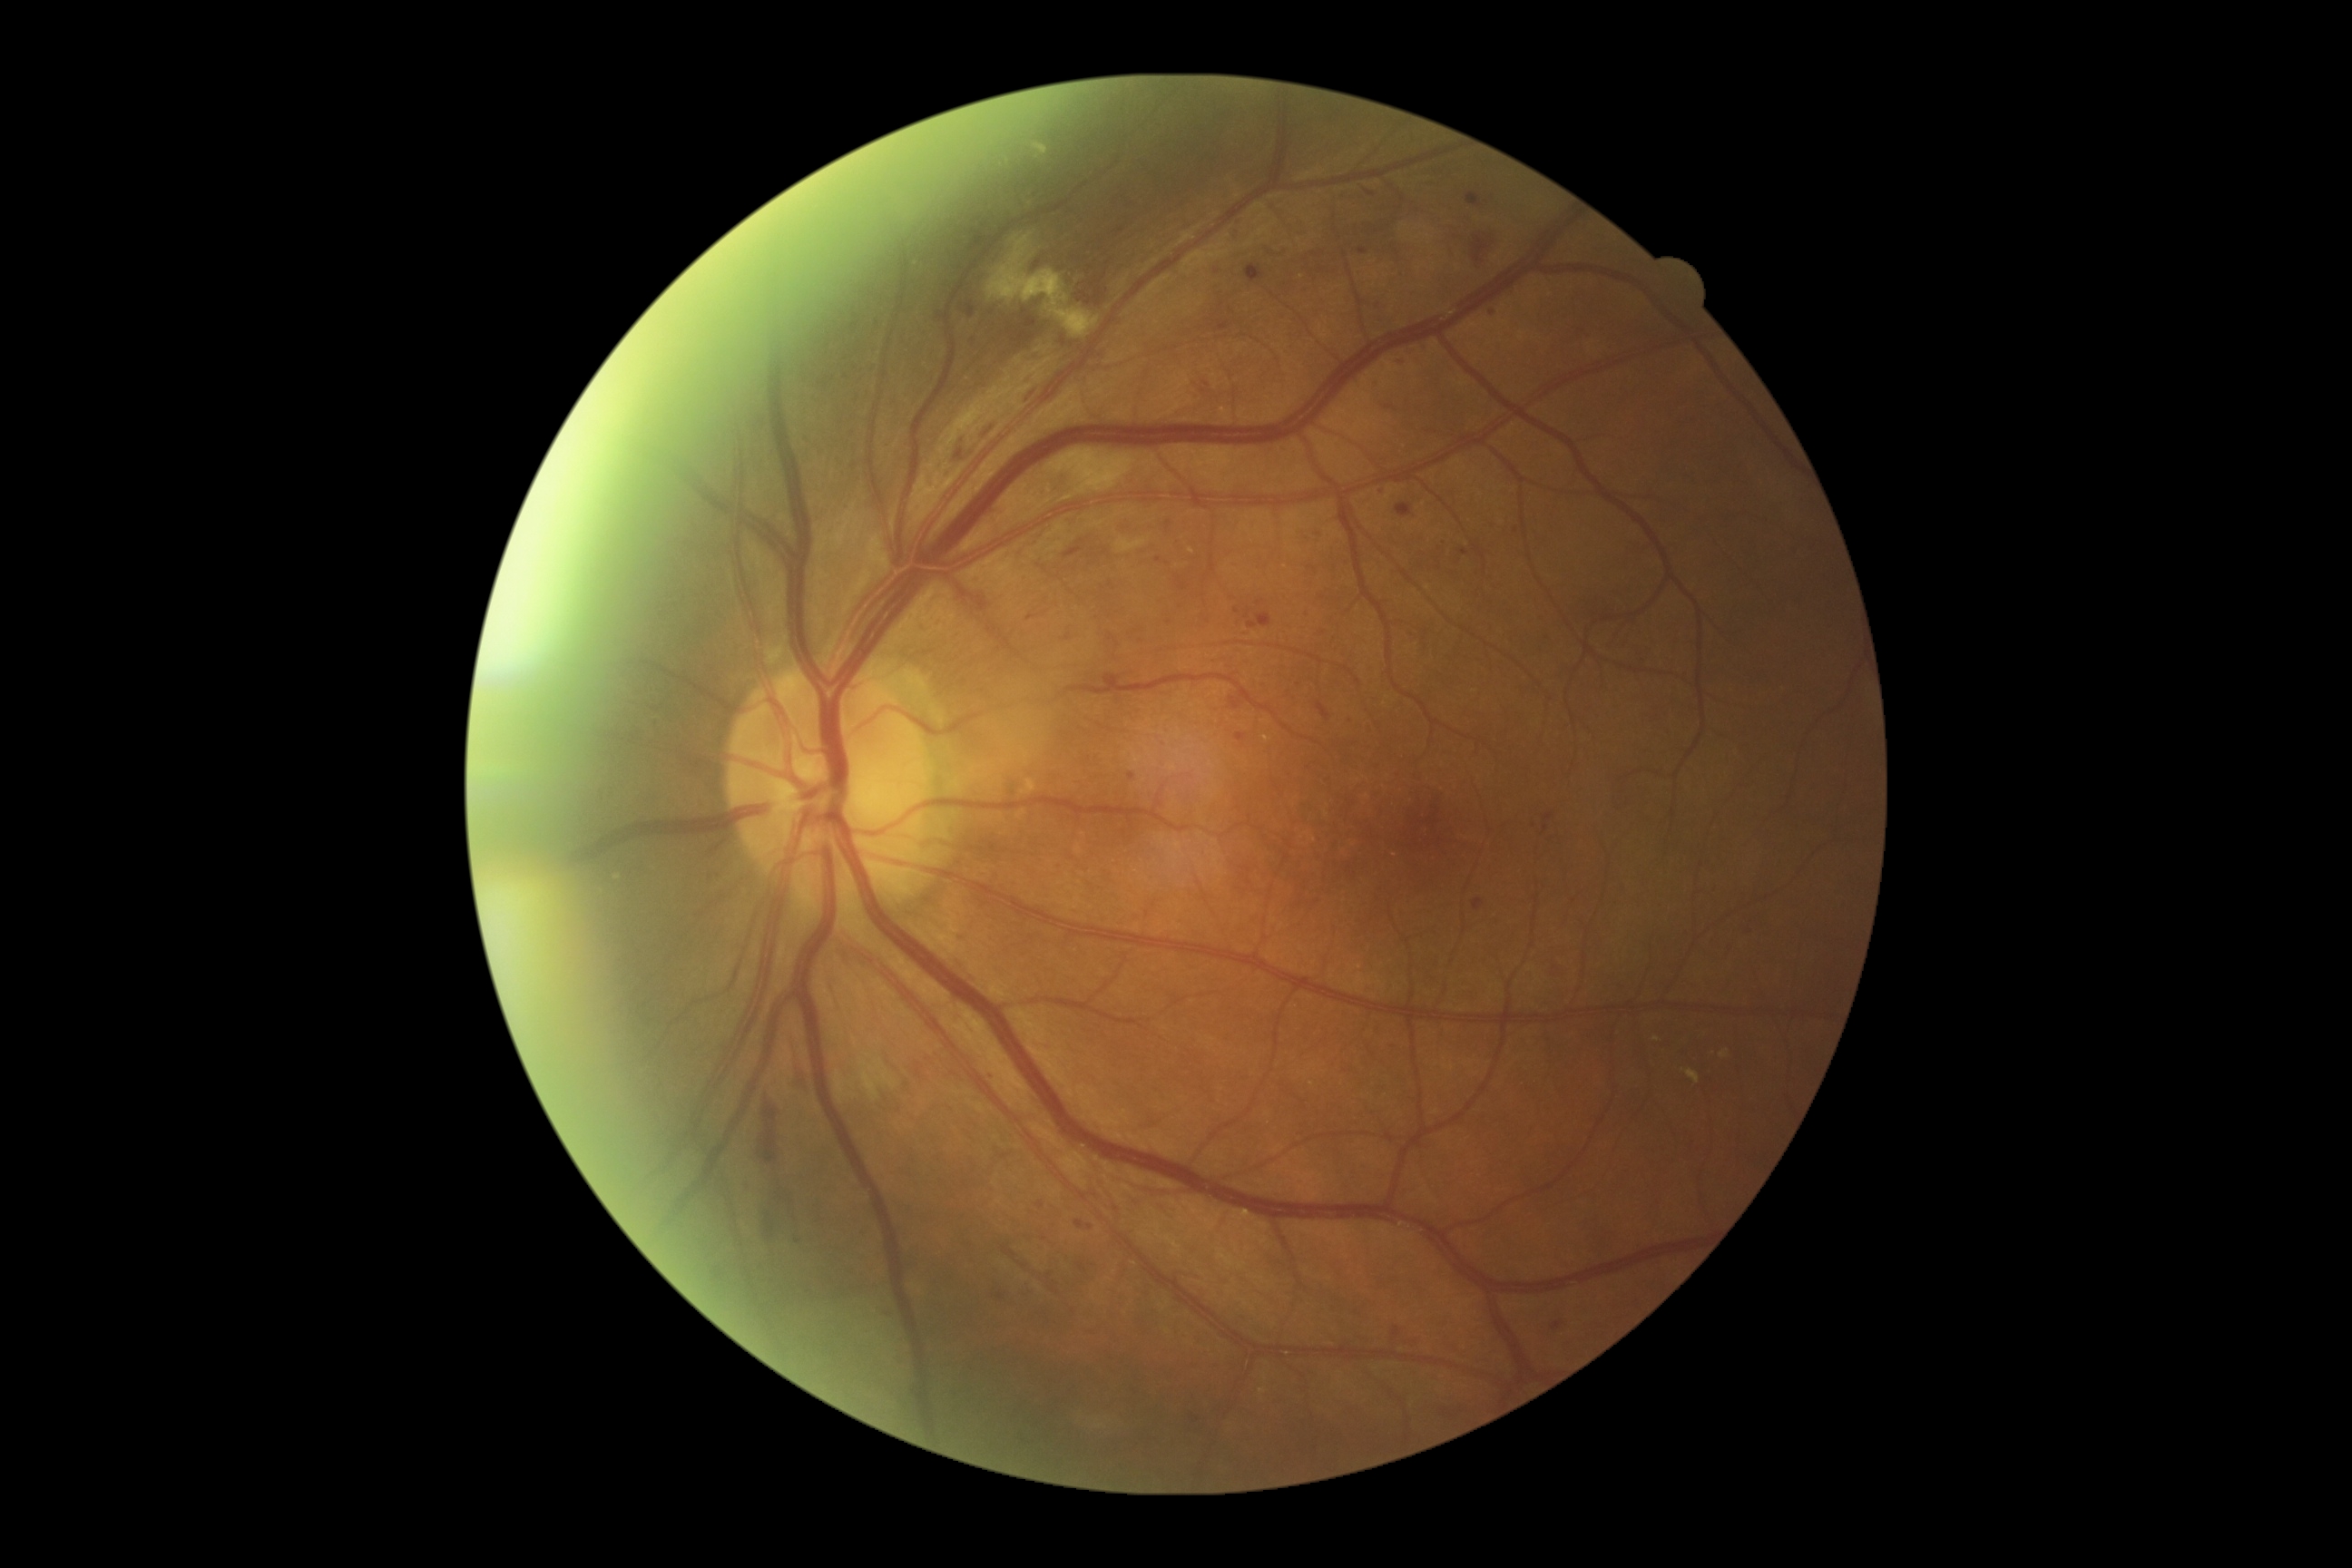
DR class=non-proliferative diabetic retinopathy; DR grade=2.